Remidio smartphone fundus camera · 1659x2212 · color fundus photograph
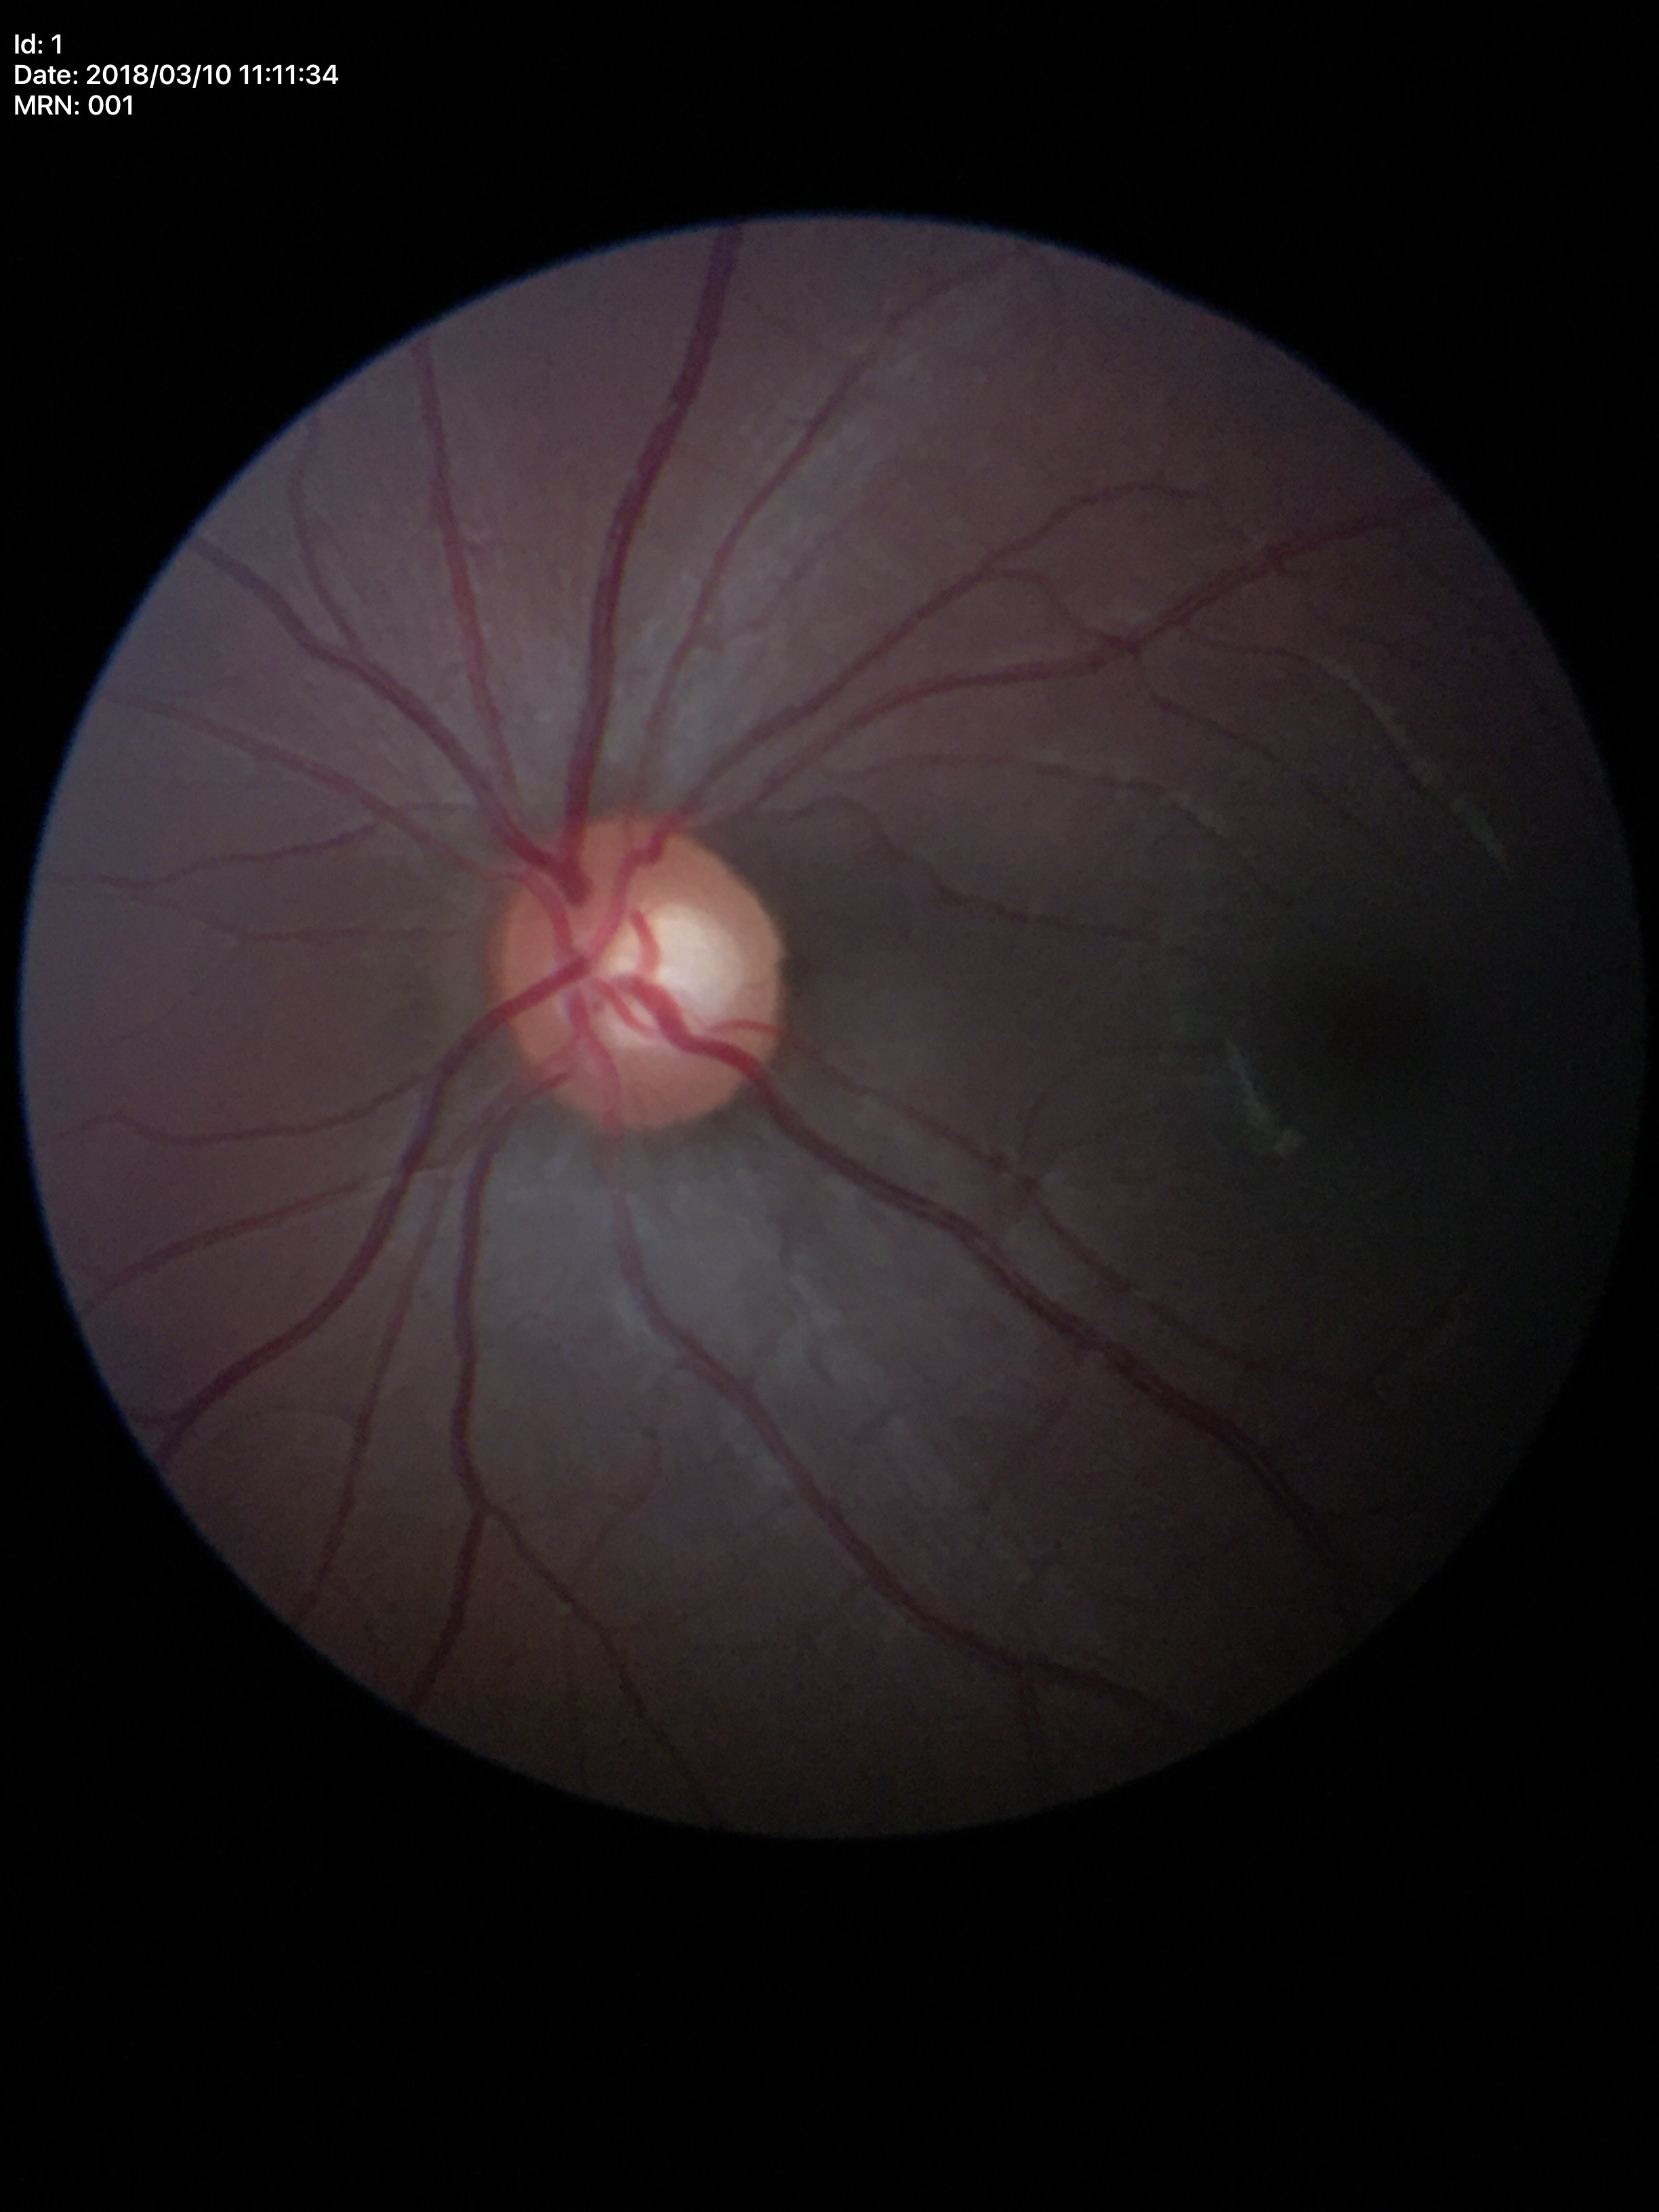 Glaucoma screening: not suspect. Vertical CDR (VCDR) is 0.51.